2212 x 1659 pixels — 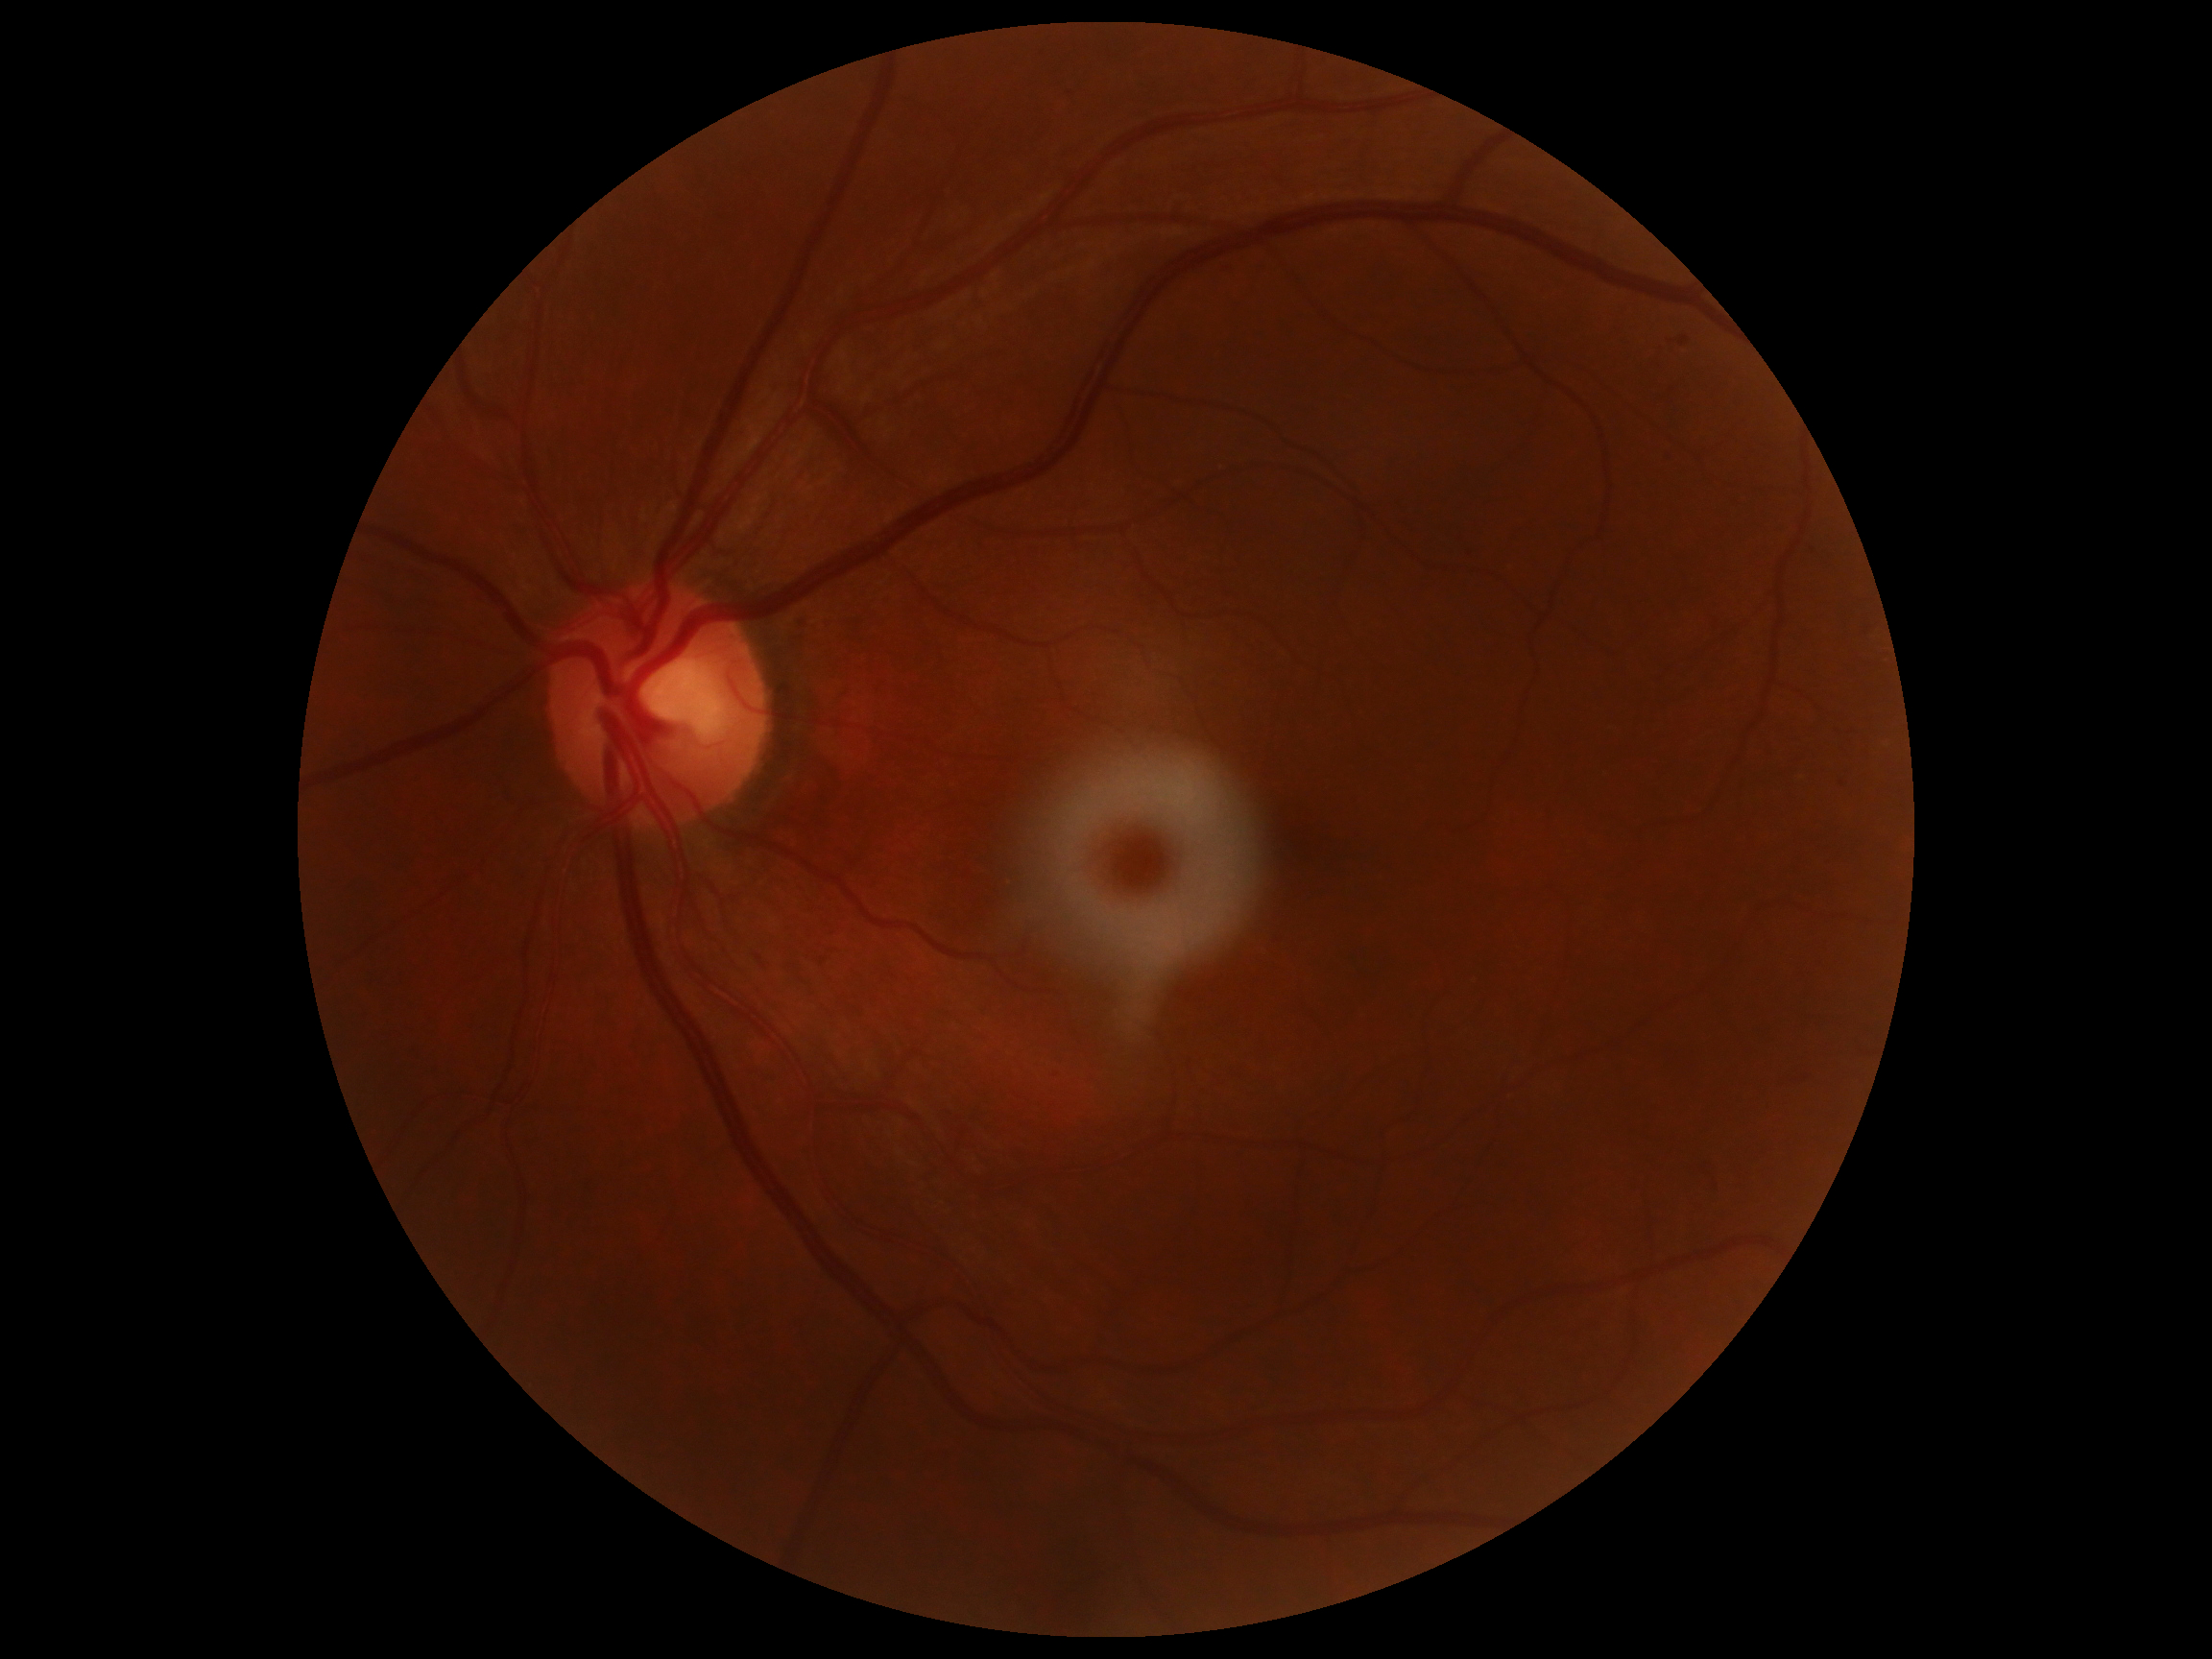

Annotations:
- DR stage — grade 1